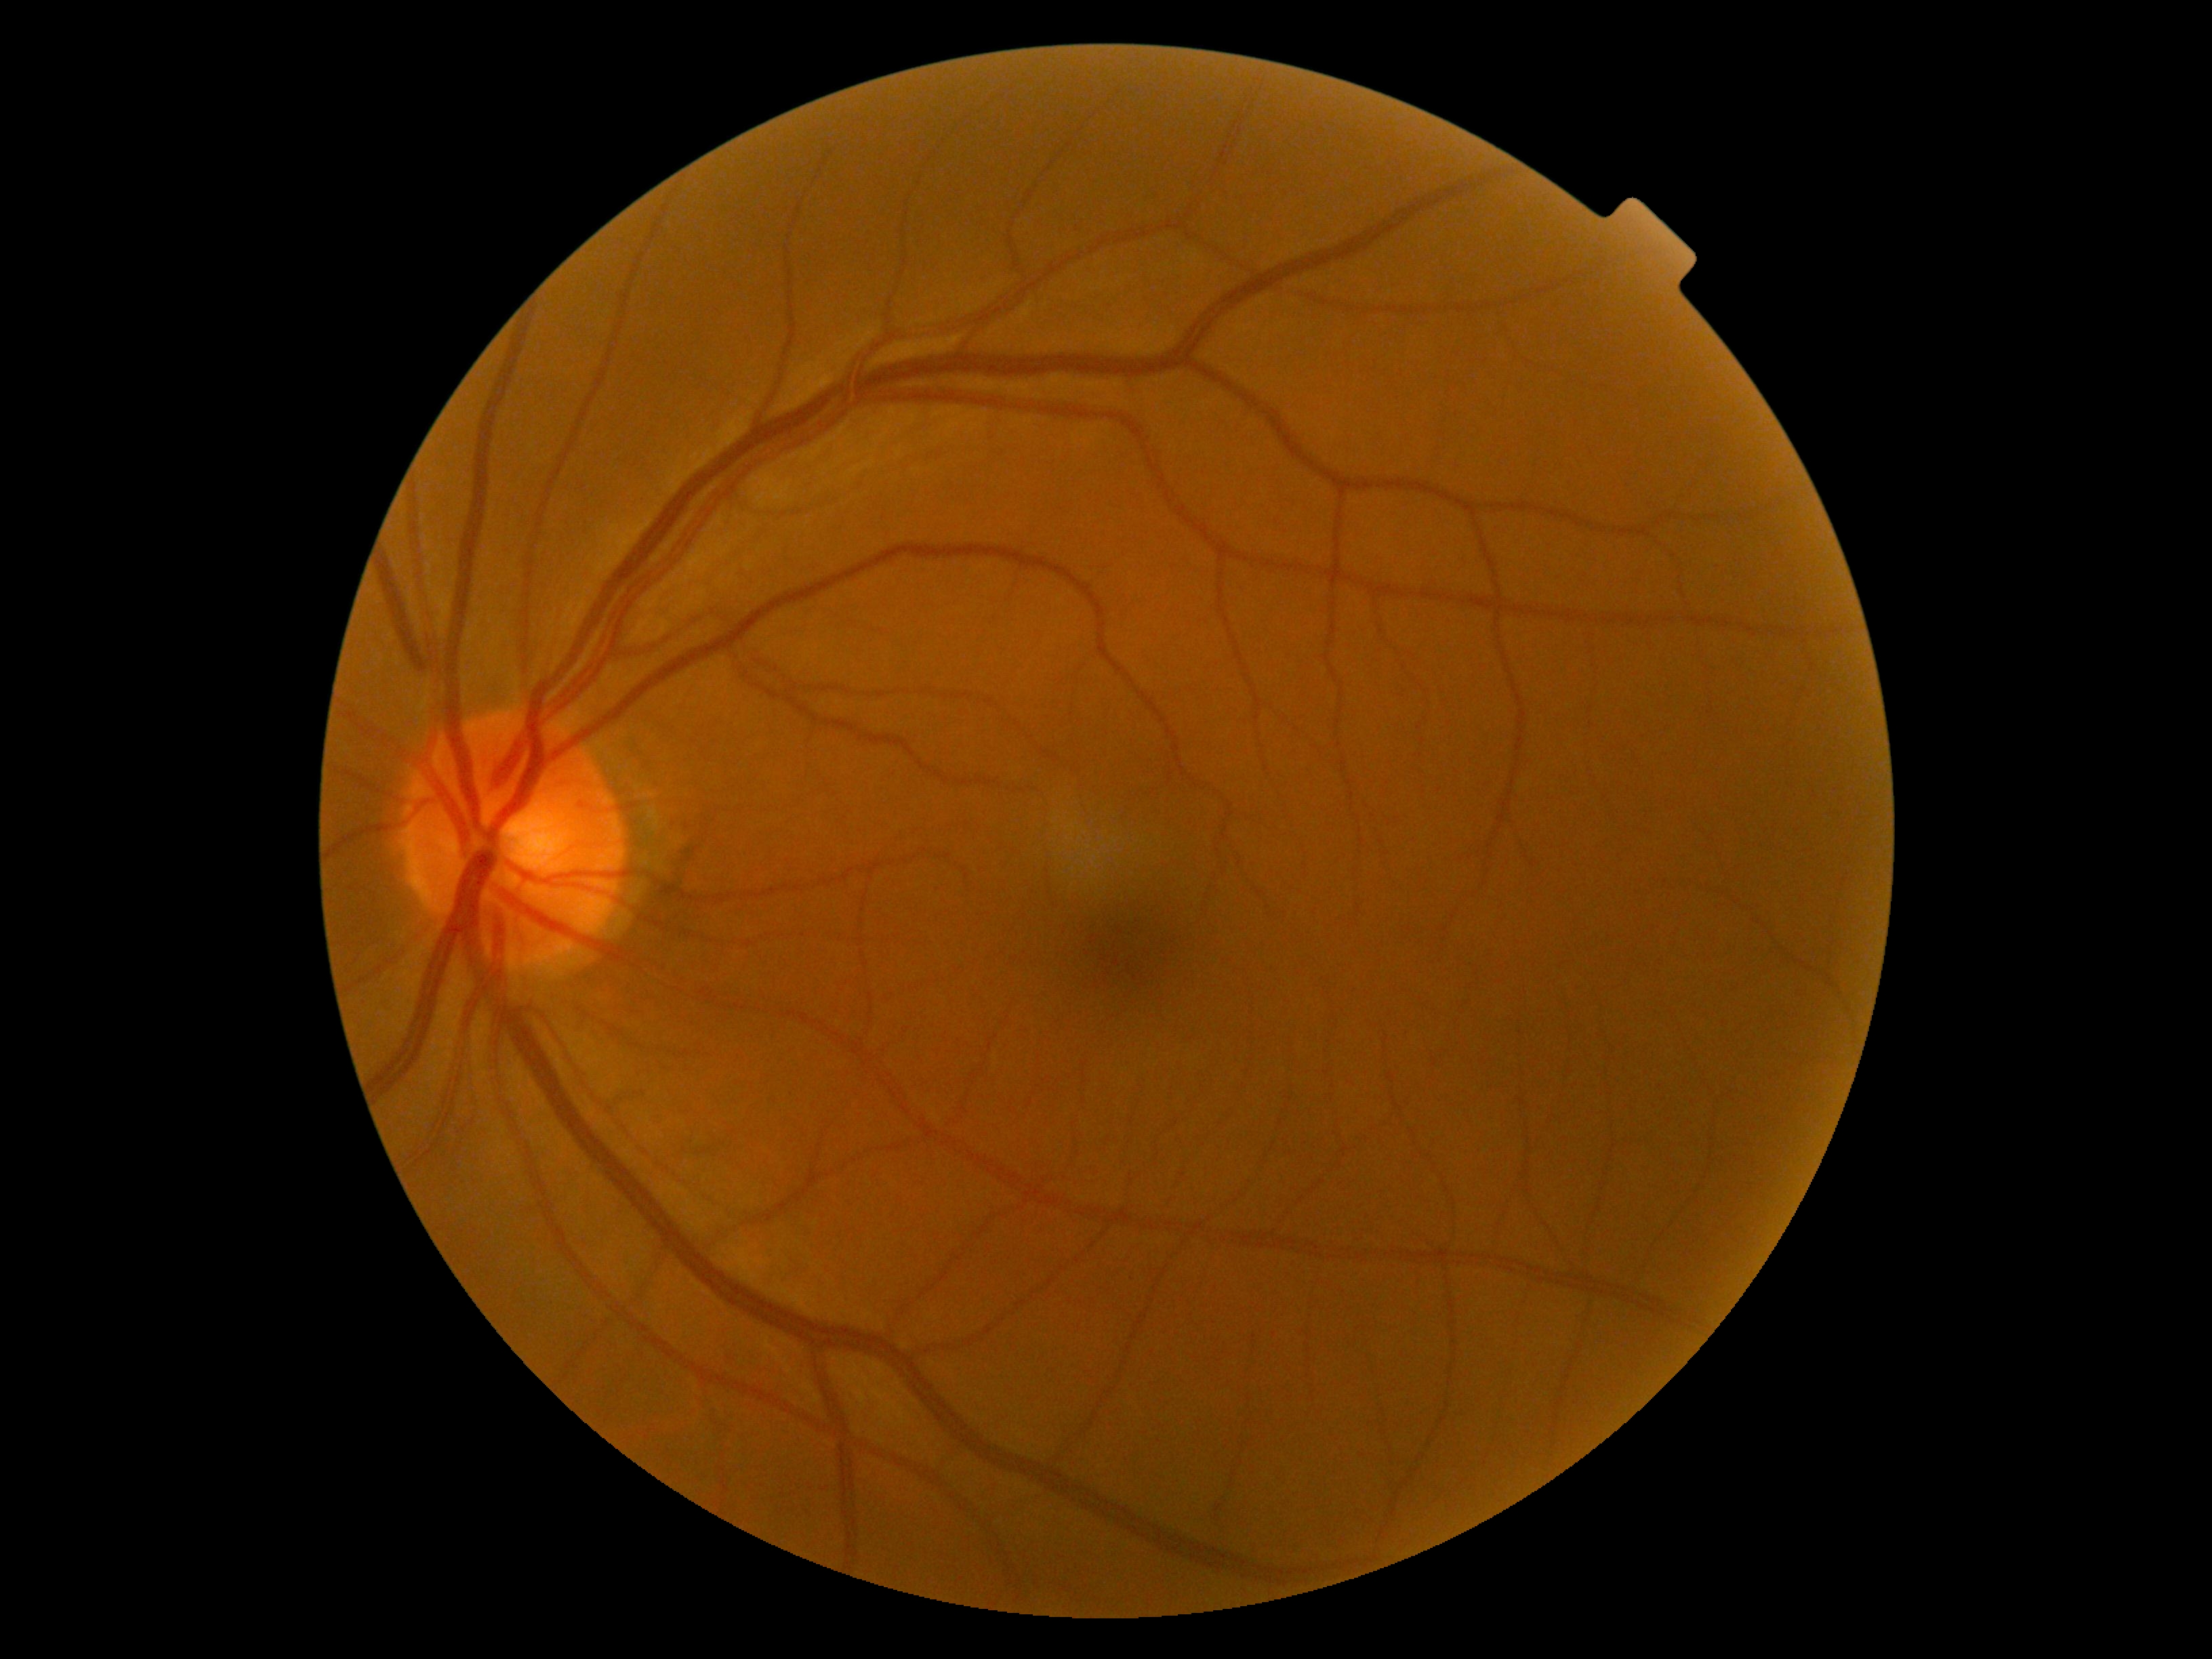

DR grade: 0.